Nonmydriatic fundus photograph. Image size 848x848.
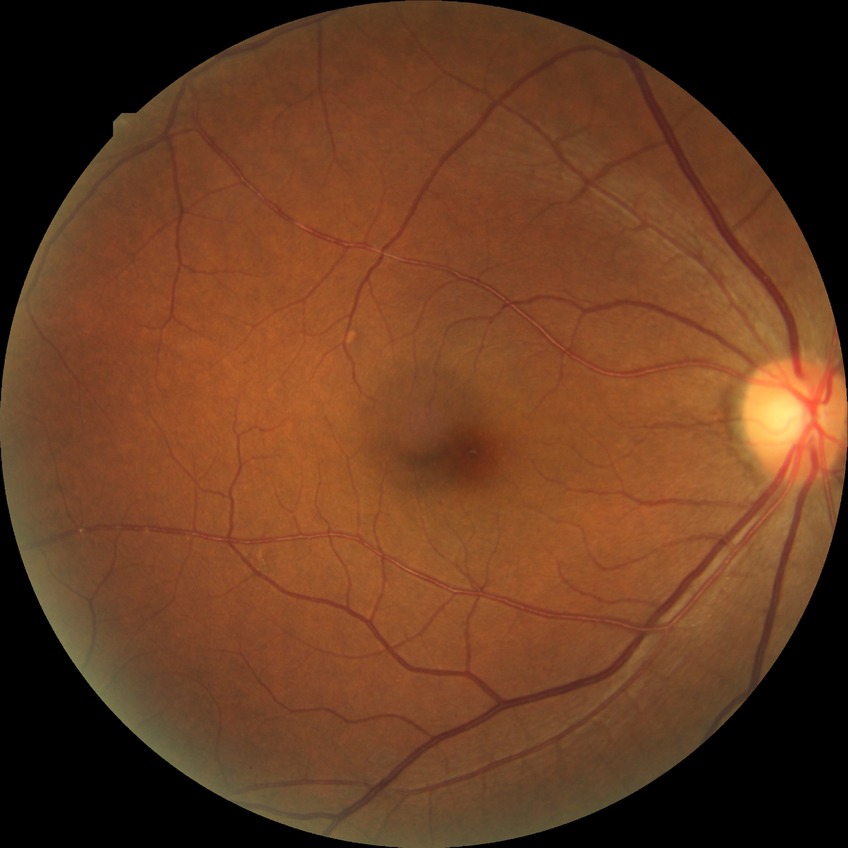
Davis grading: no diabetic retinopathy.